100° field of view (Phoenix ICON); Phoenix ICON wide-field infant fundus image.
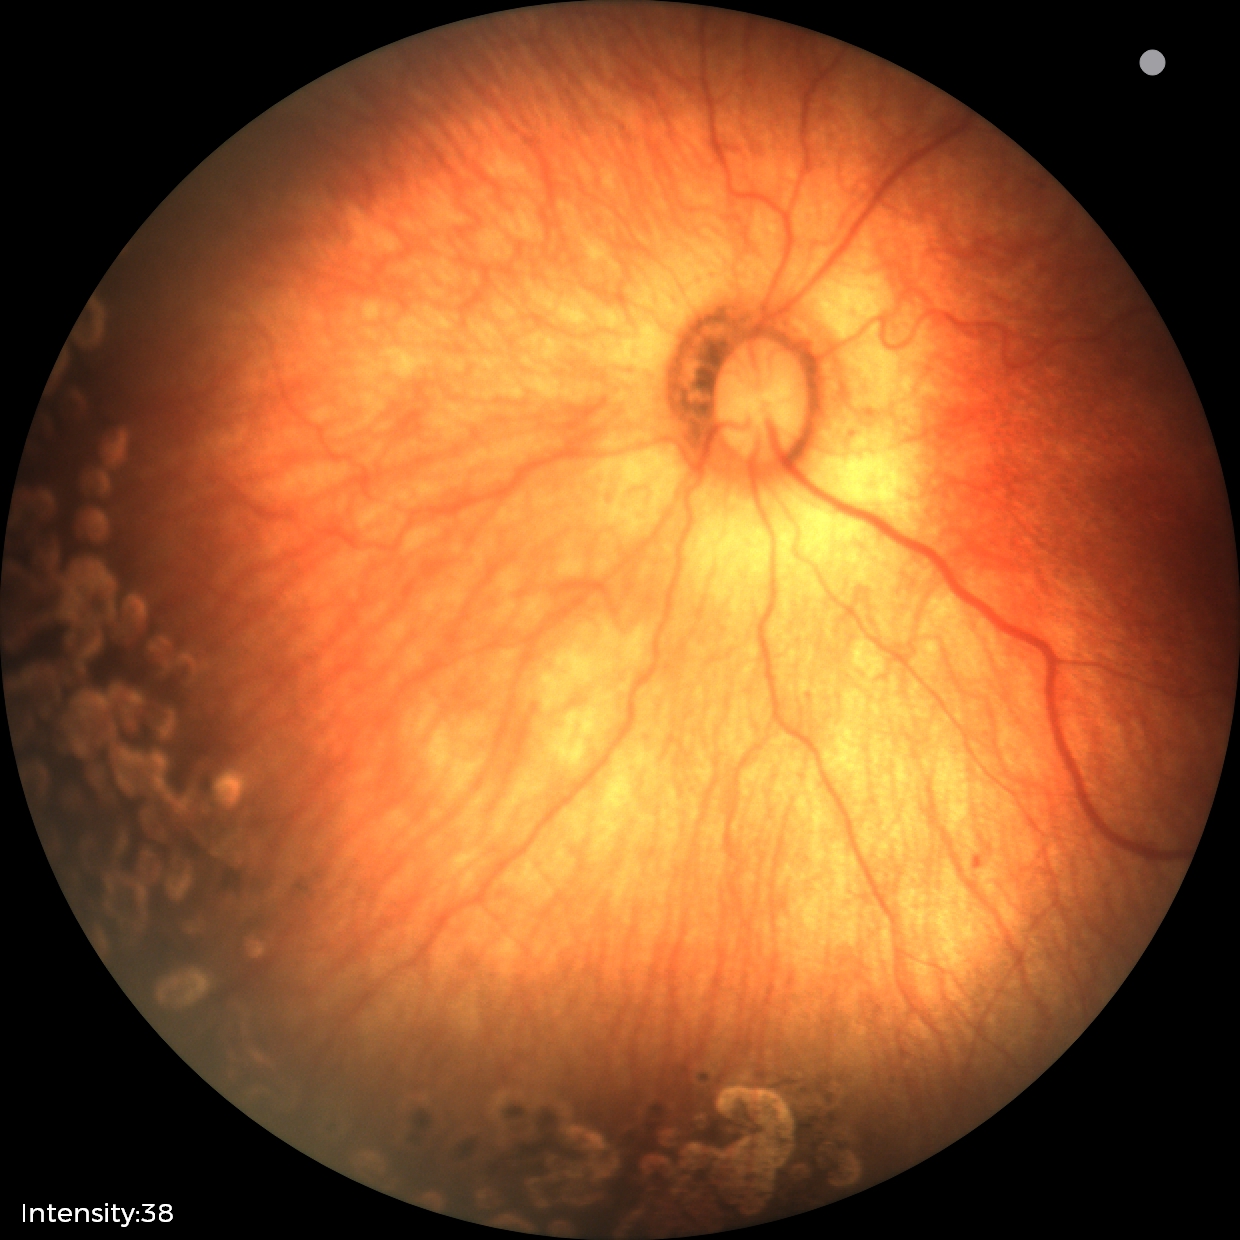
No plus disease.
Screening series with status post retinopathy of prematurity.